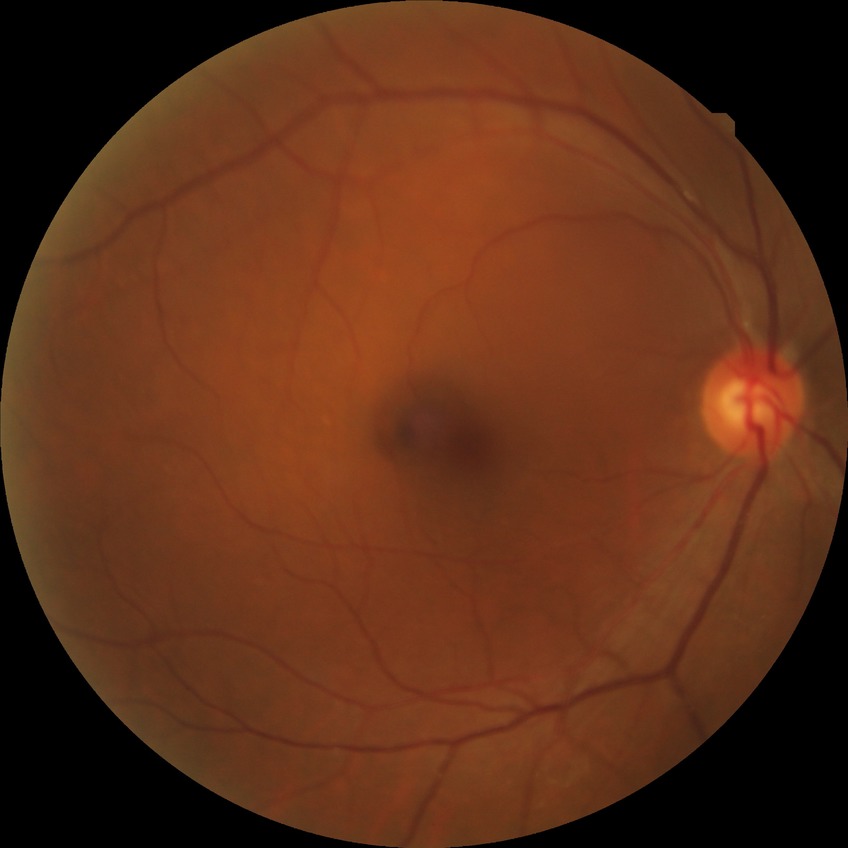 Retinopathy grade is no diabetic retinopathy.